50-degree field of view, fundus photo:
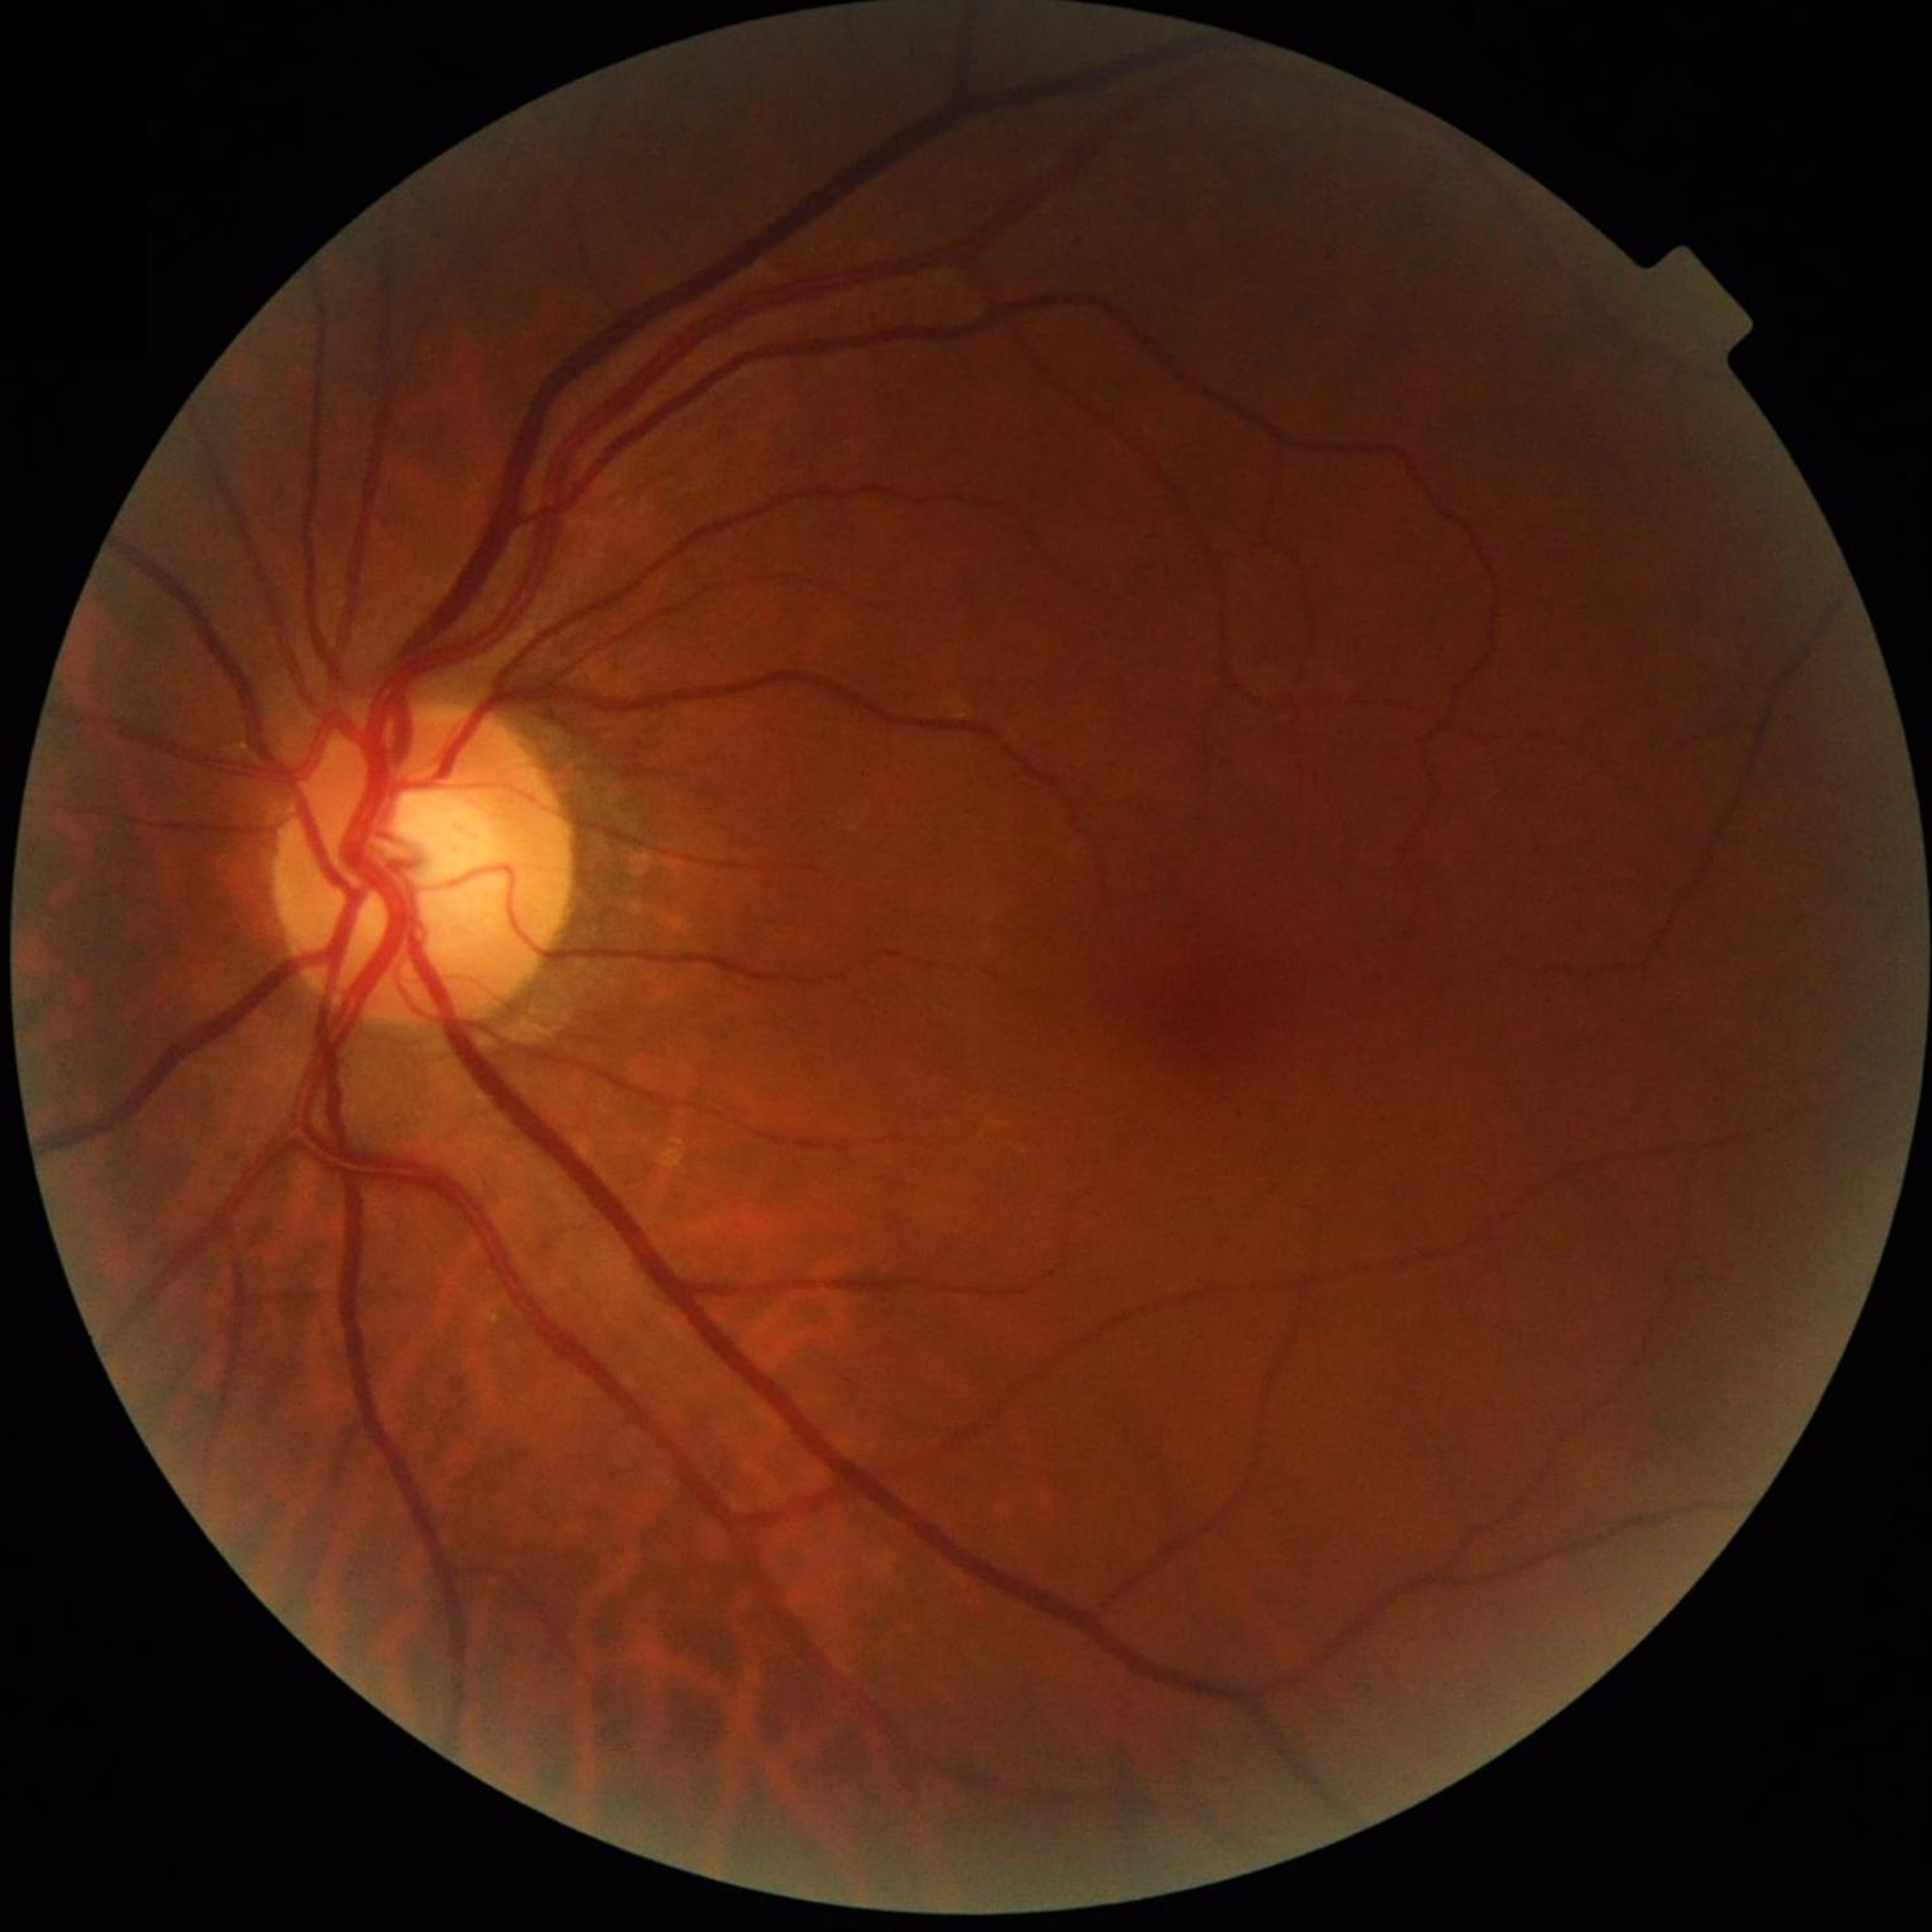 Disease class: no AMD, DR, or glaucomatous findings.